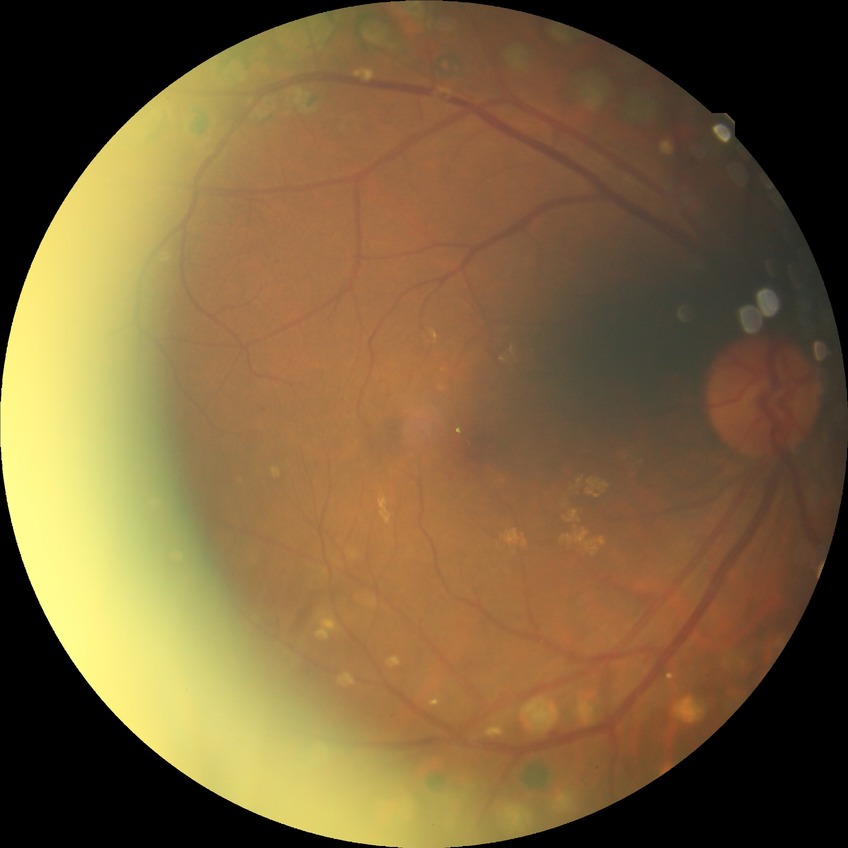
Findings:
• Davis grading — proliferative diabetic retinopathy